Pediatric retinal photograph (wide-field); acquired on the Clarity RetCam 3: 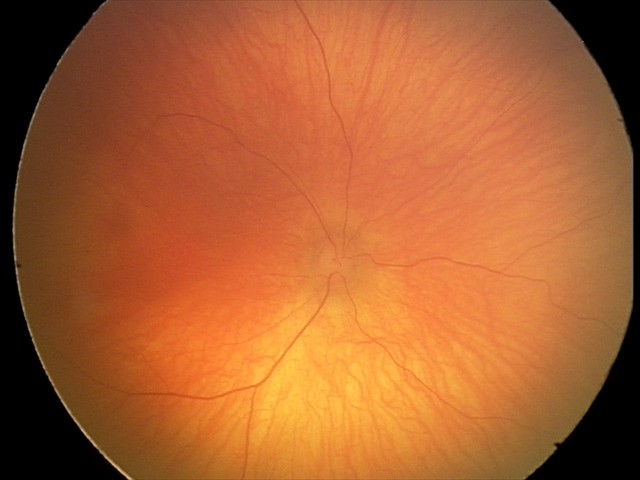
Examination with physiological retinal findings.